Wide-field fundus image from infant ROP screening · 640 by 480 pixels: 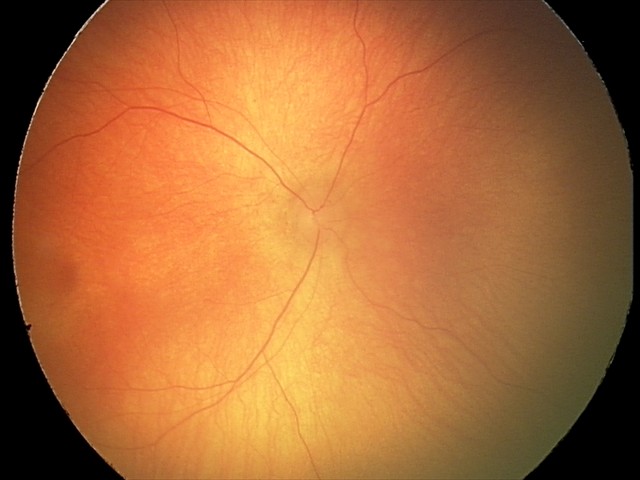
Q: What is the diagnosis from this examination?
A: retinopathy of prematurity (ROP) stage 0
Q: What is the plus-form classification?
A: no plus disease